45° FOV · 2352 x 1568 pixels
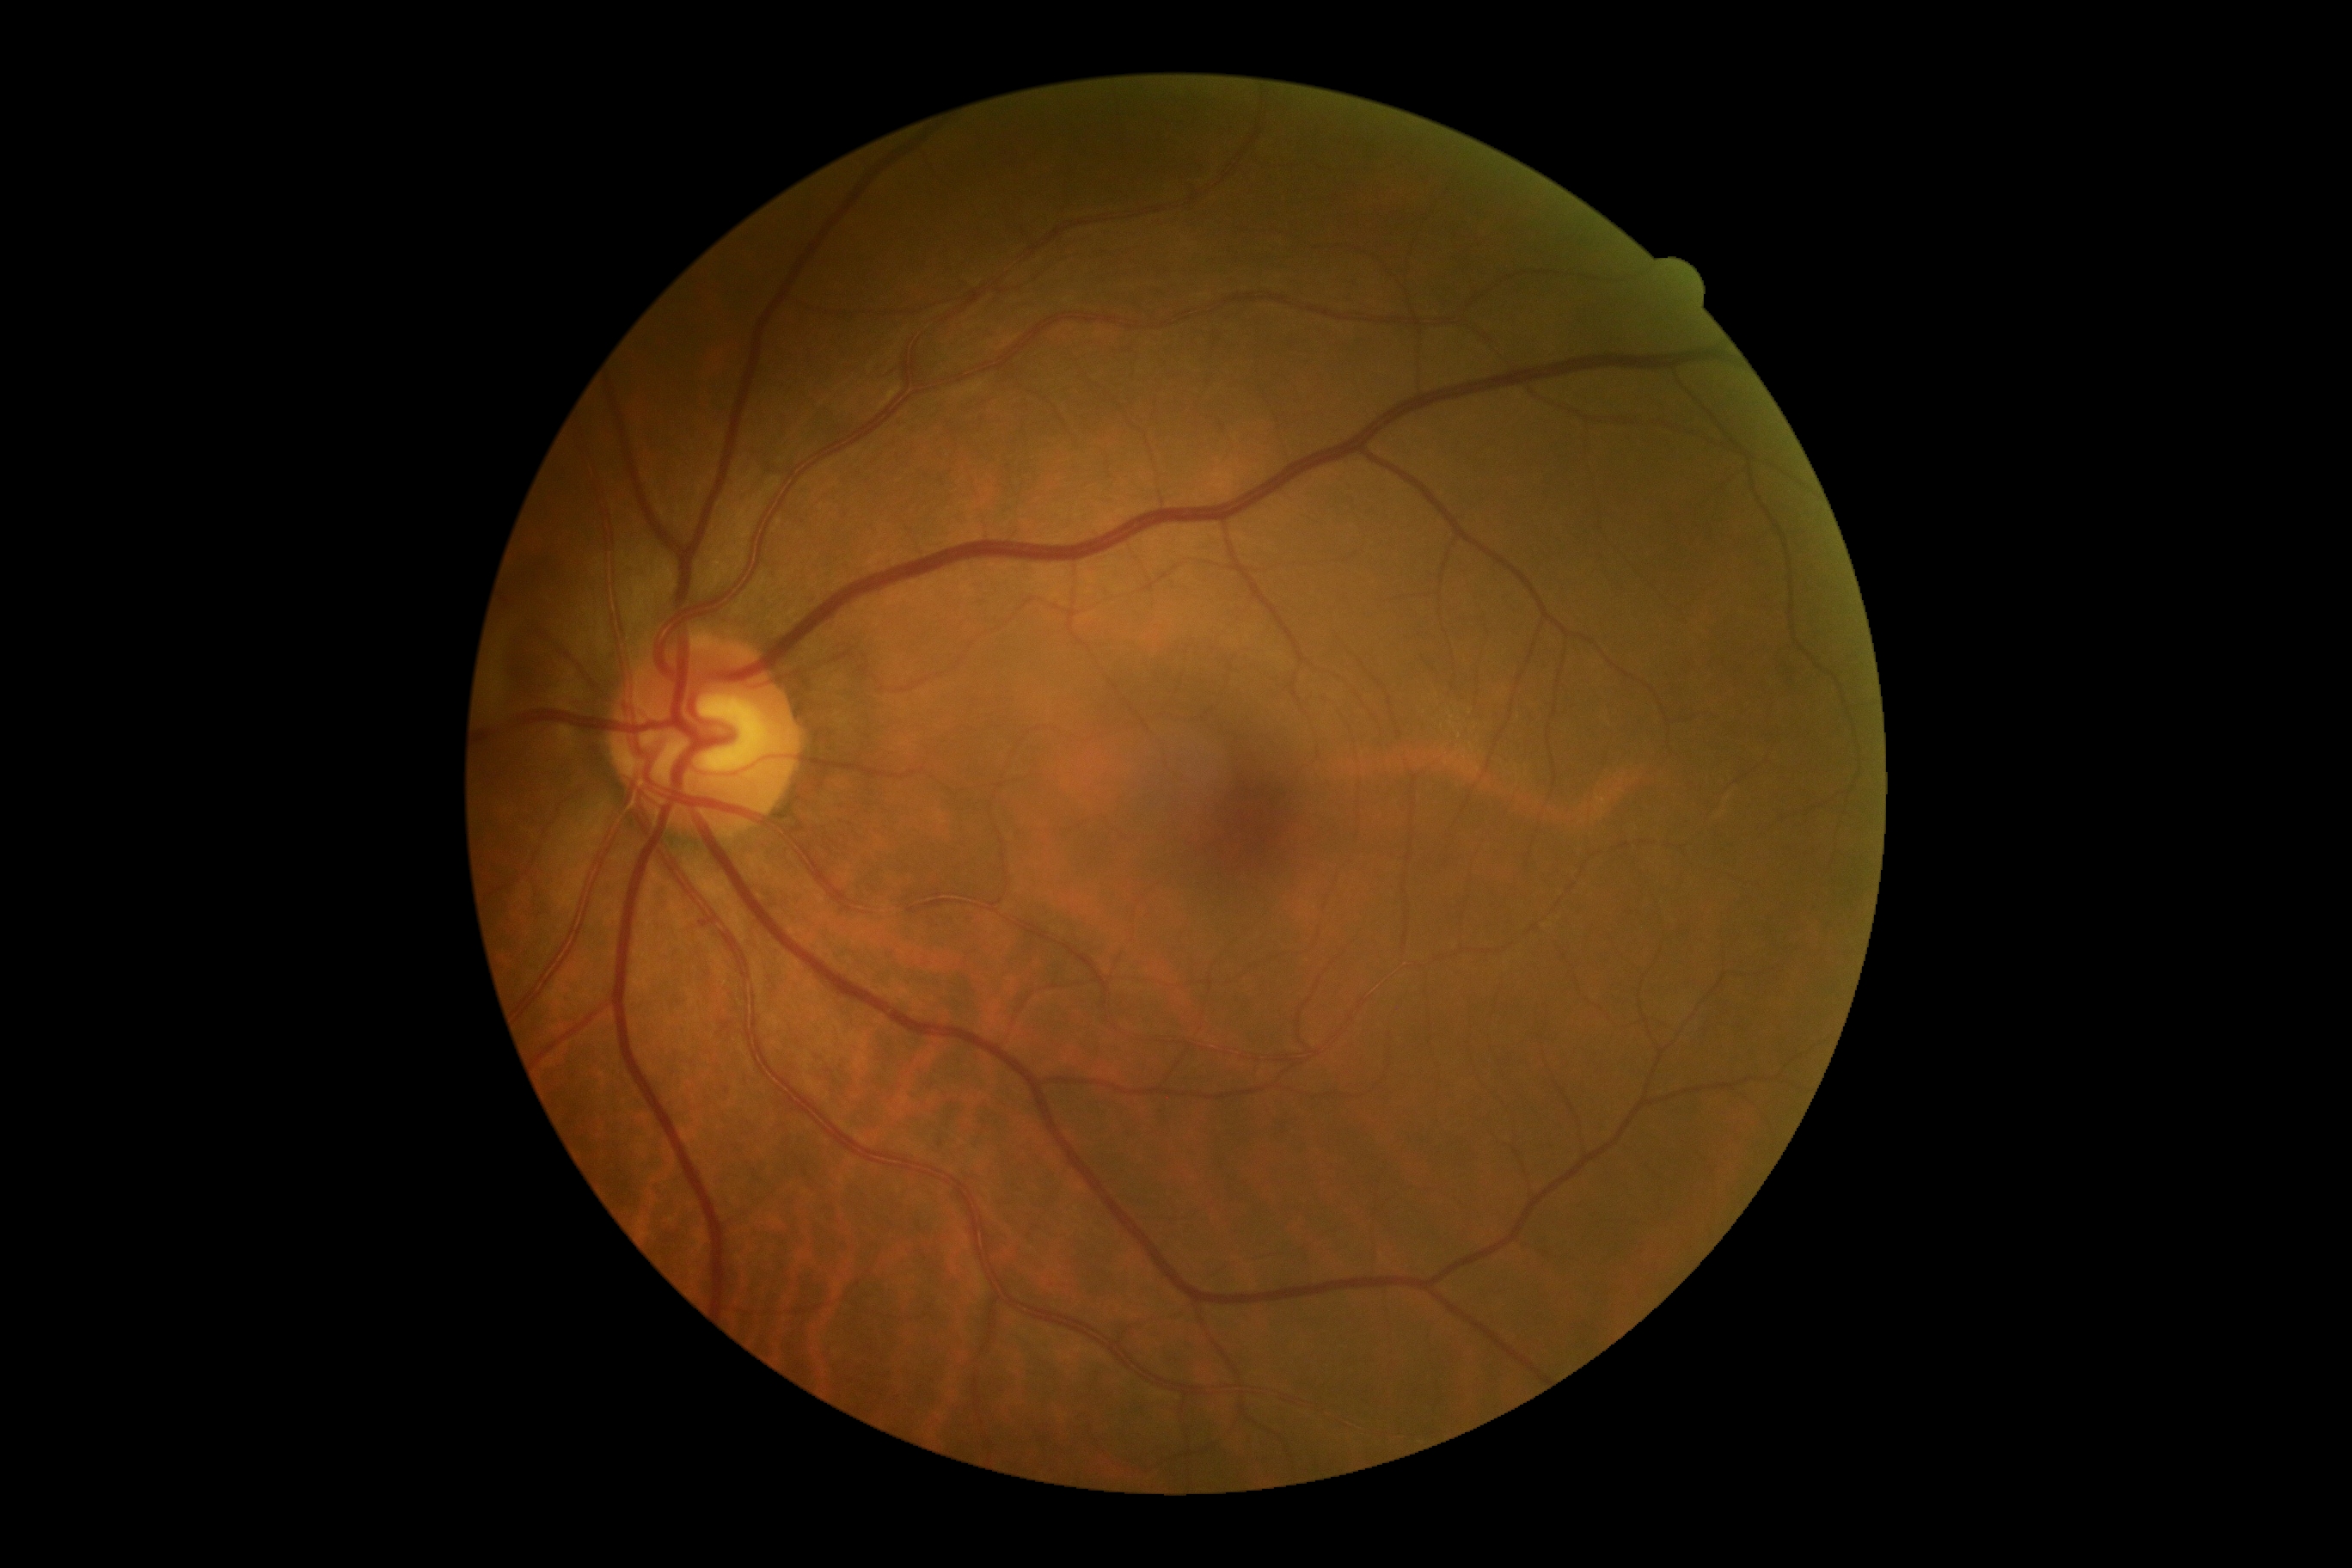 DR stage is 0/4.